1380 x 1382 pixels: 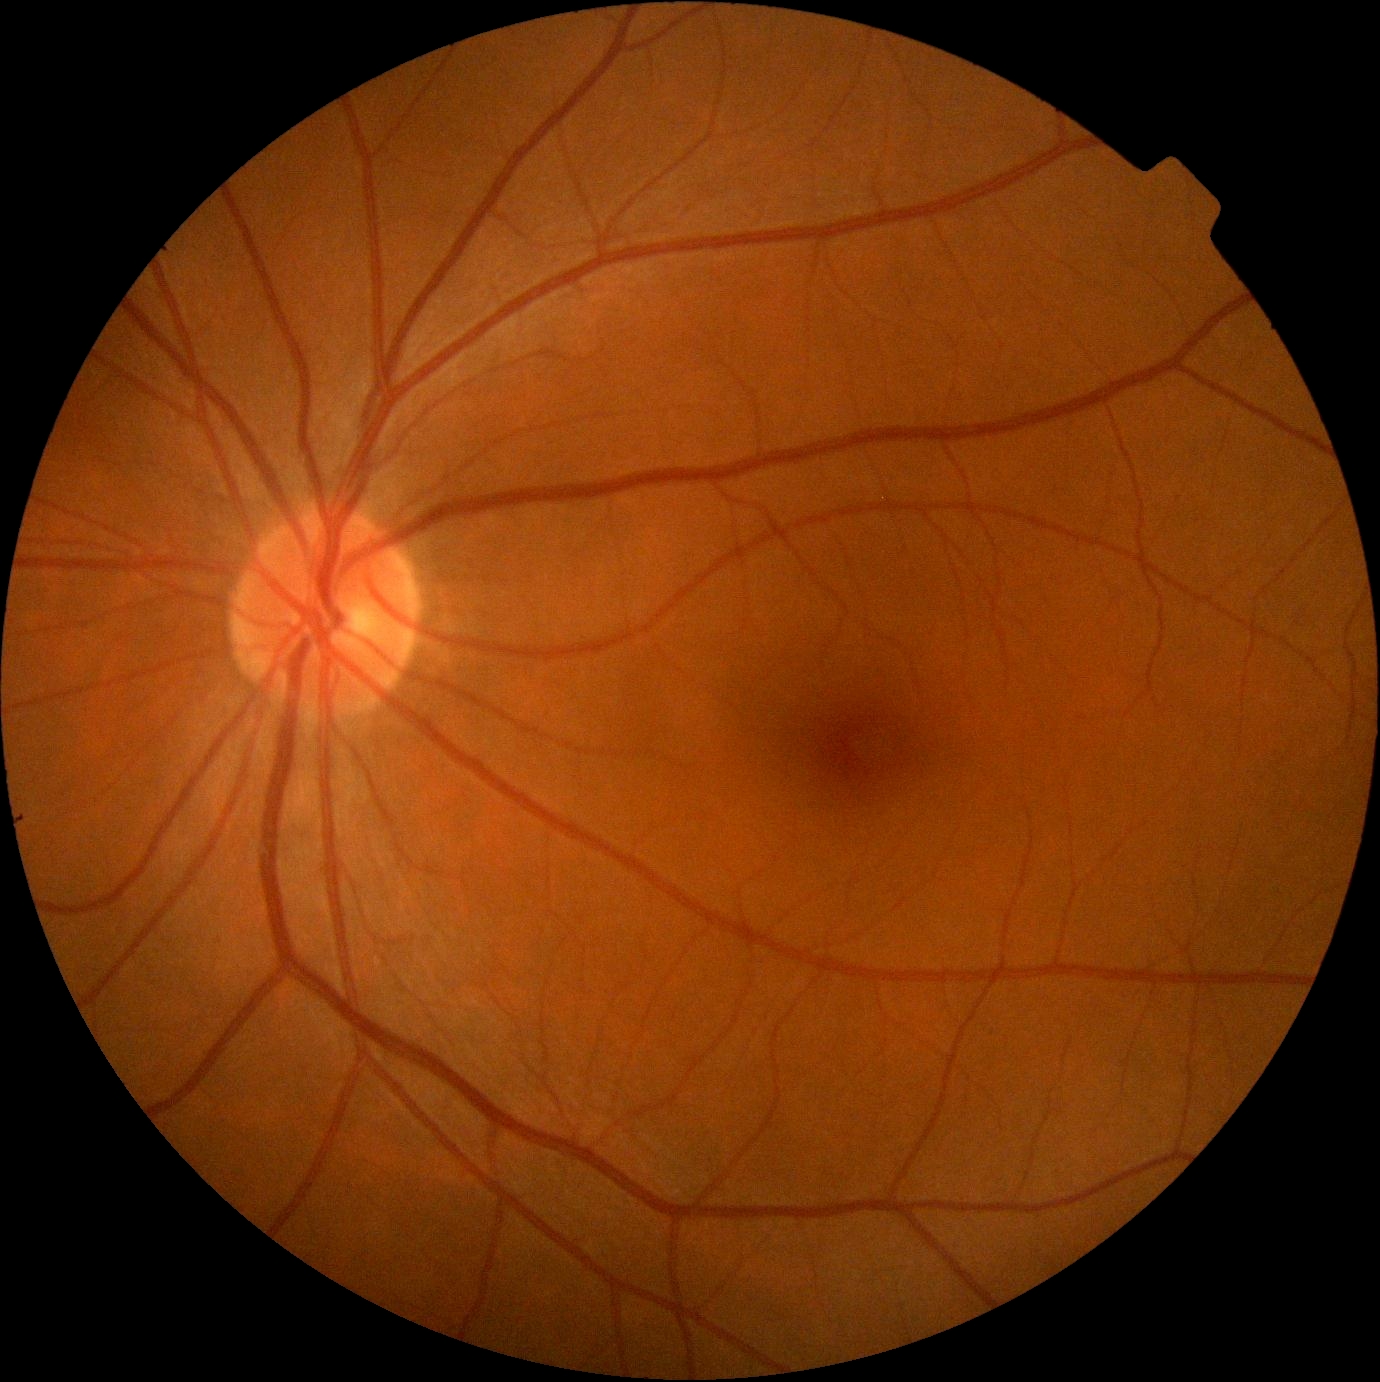

dr_impression: no DR findings
dr_grade: 0